45 degree fundus photograph
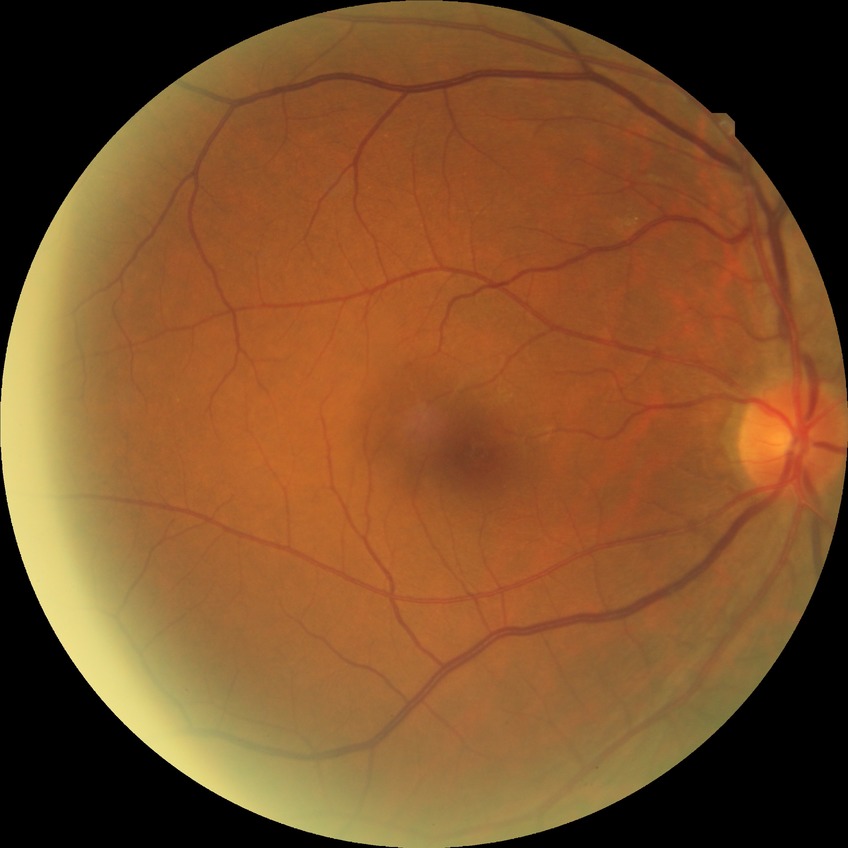
Diabetic retinopathy (DR) is no diabetic retinopathy (NDR).